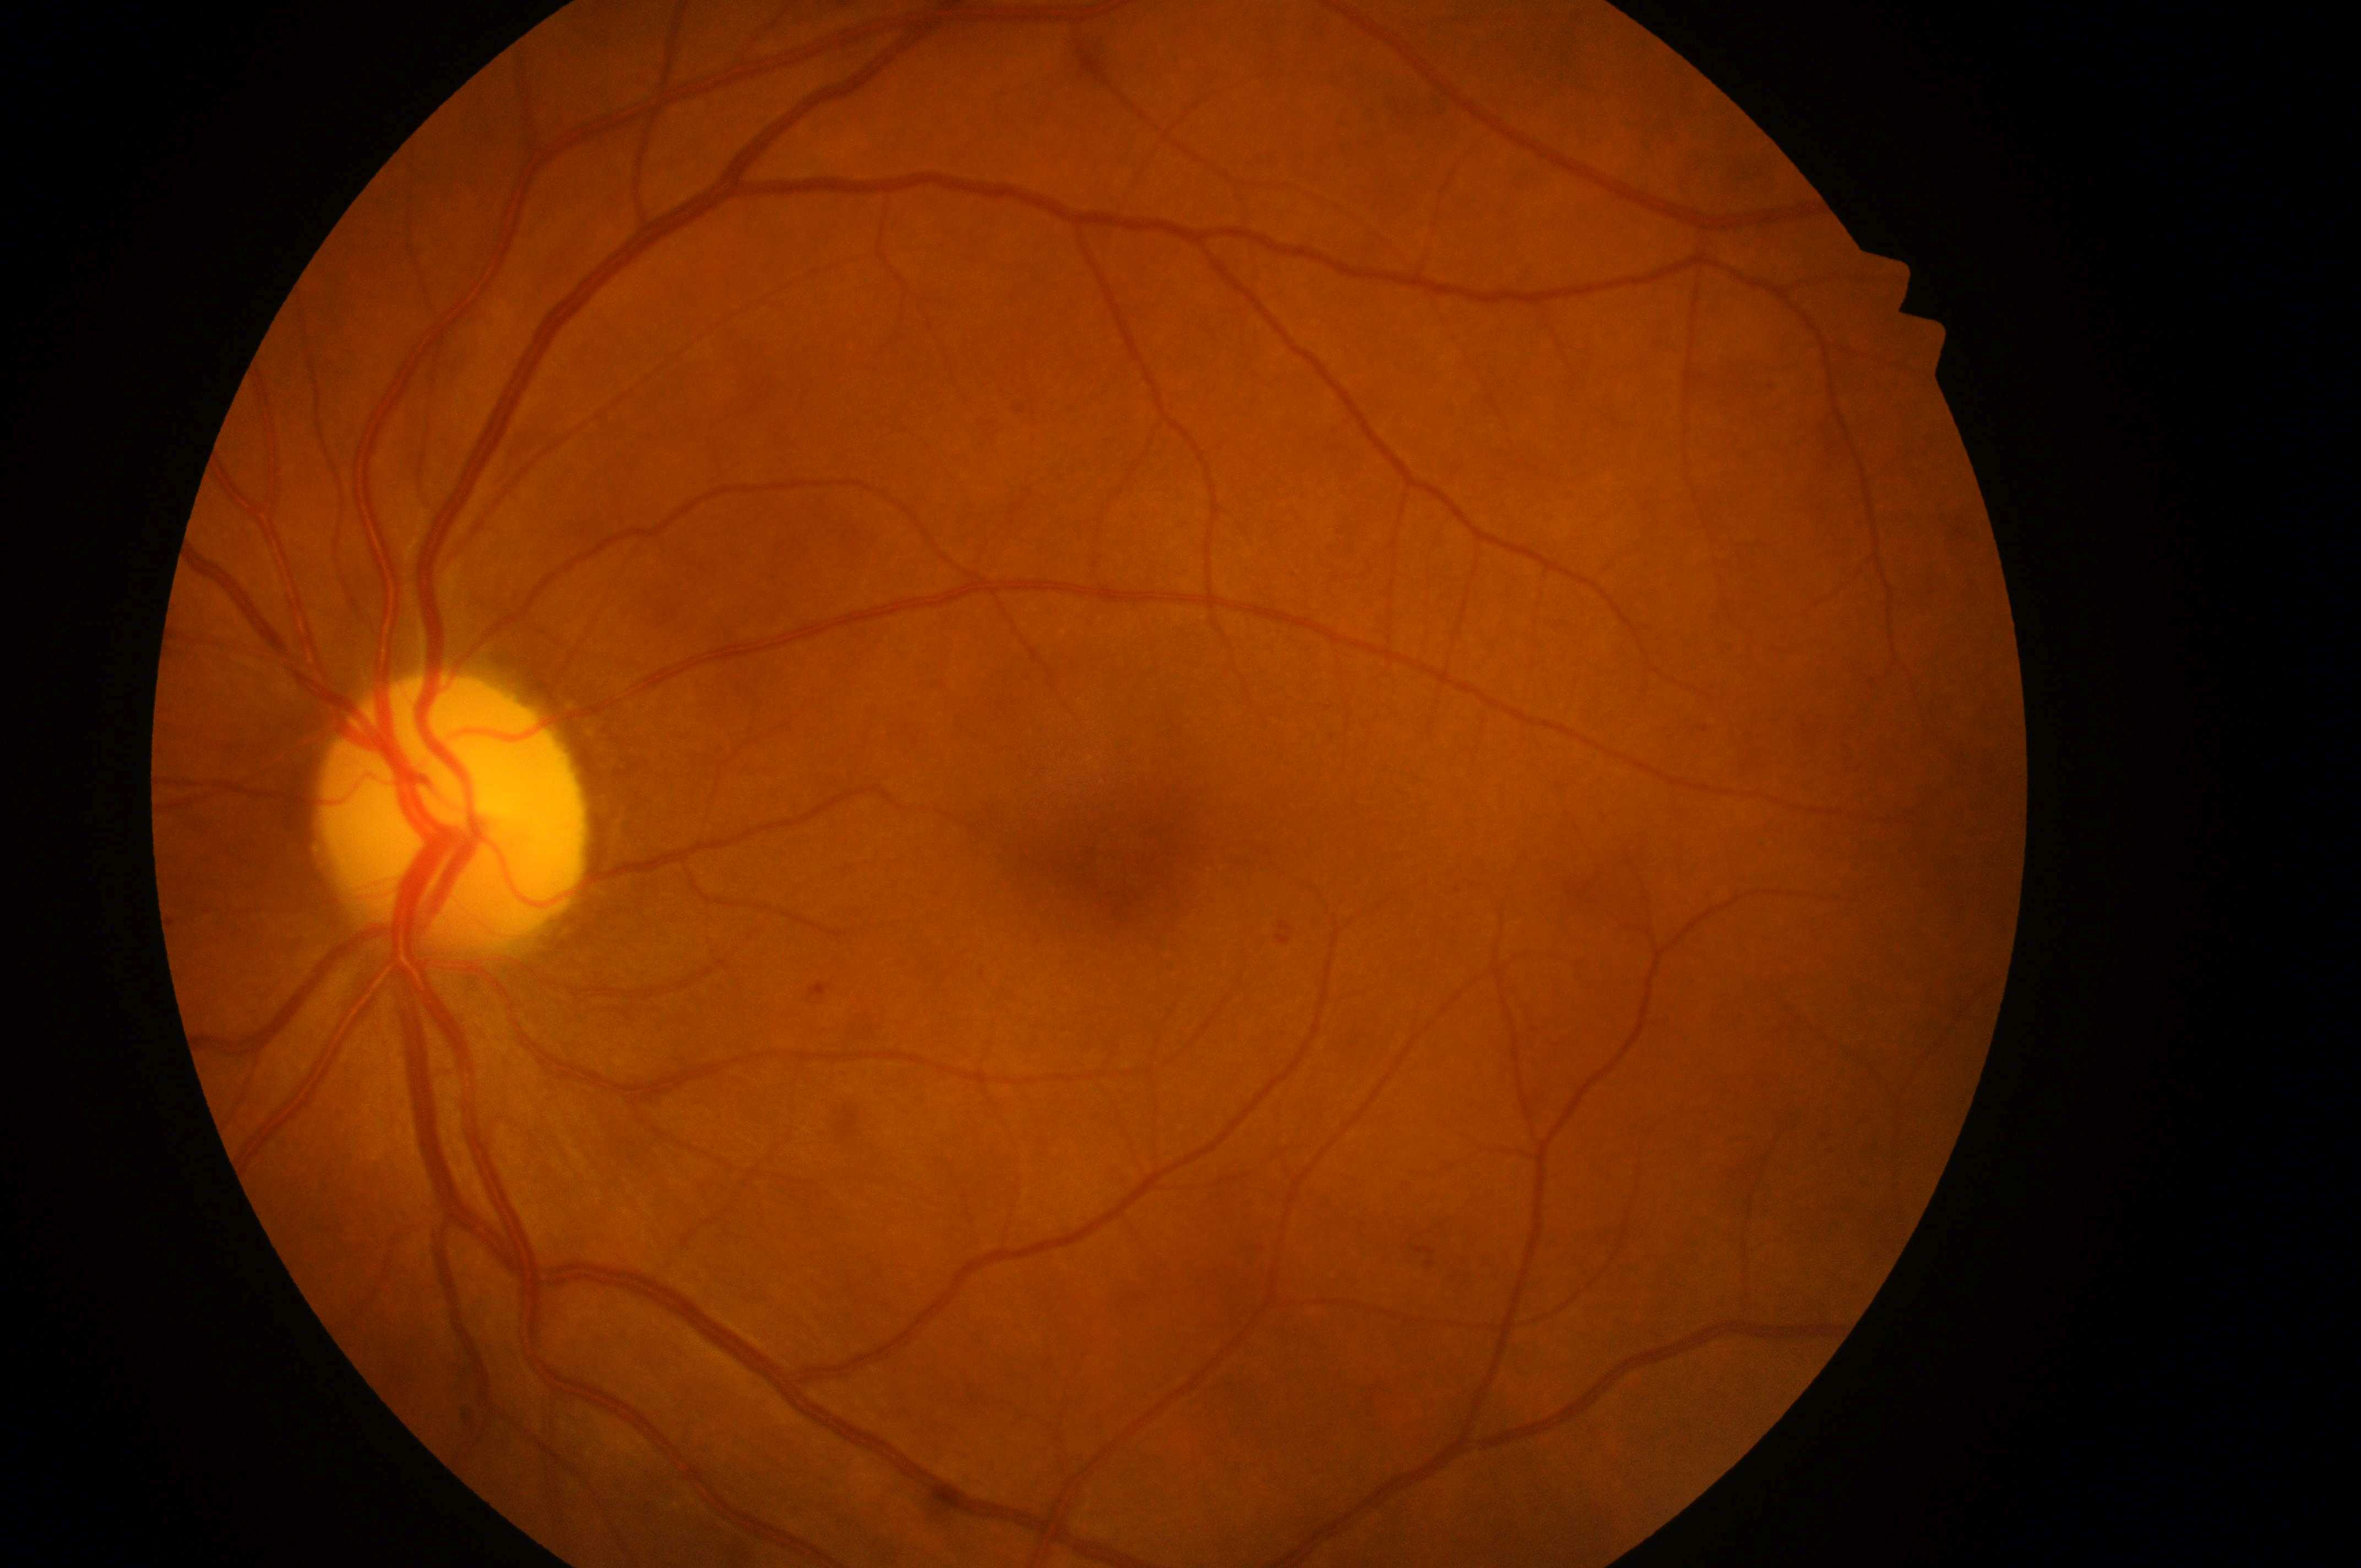

Diabetic macular edema (DME) is grade 0 (no risk).
Diabetic retinopathy (DR): grade 1 (mild NPDR).
The foveal center is at (x: 1126, y: 859).
The disc center is at (x: 443, y: 831).
This is the left eye.